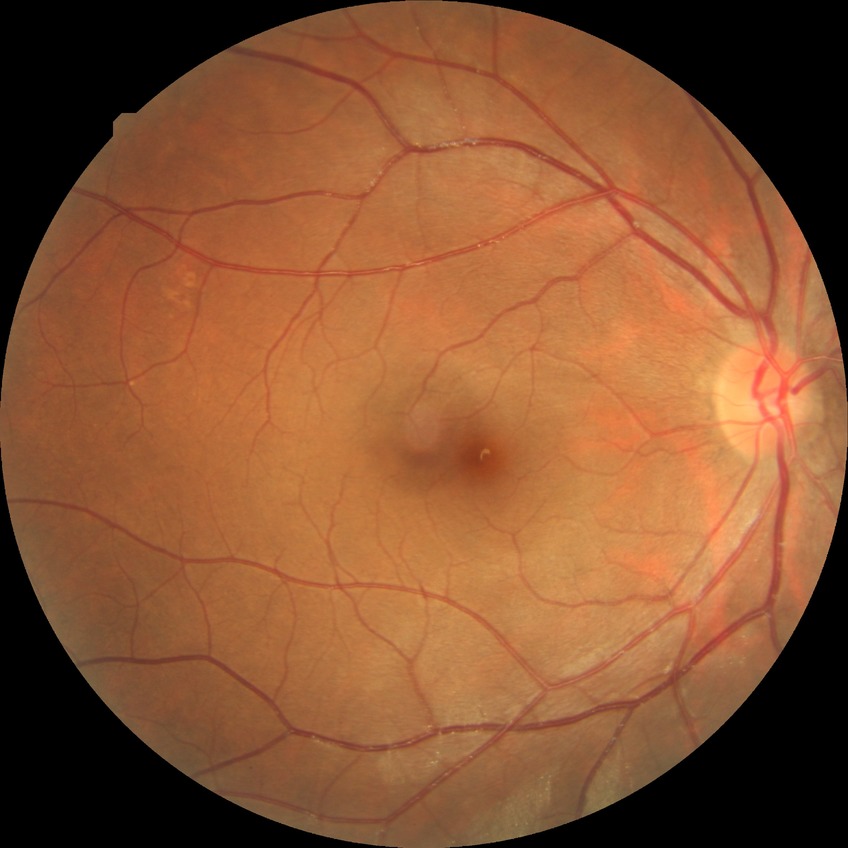
davis_grade: NDR (no diabetic retinopathy)